2352x1568px. 45-degree field of view. Fundus photo — 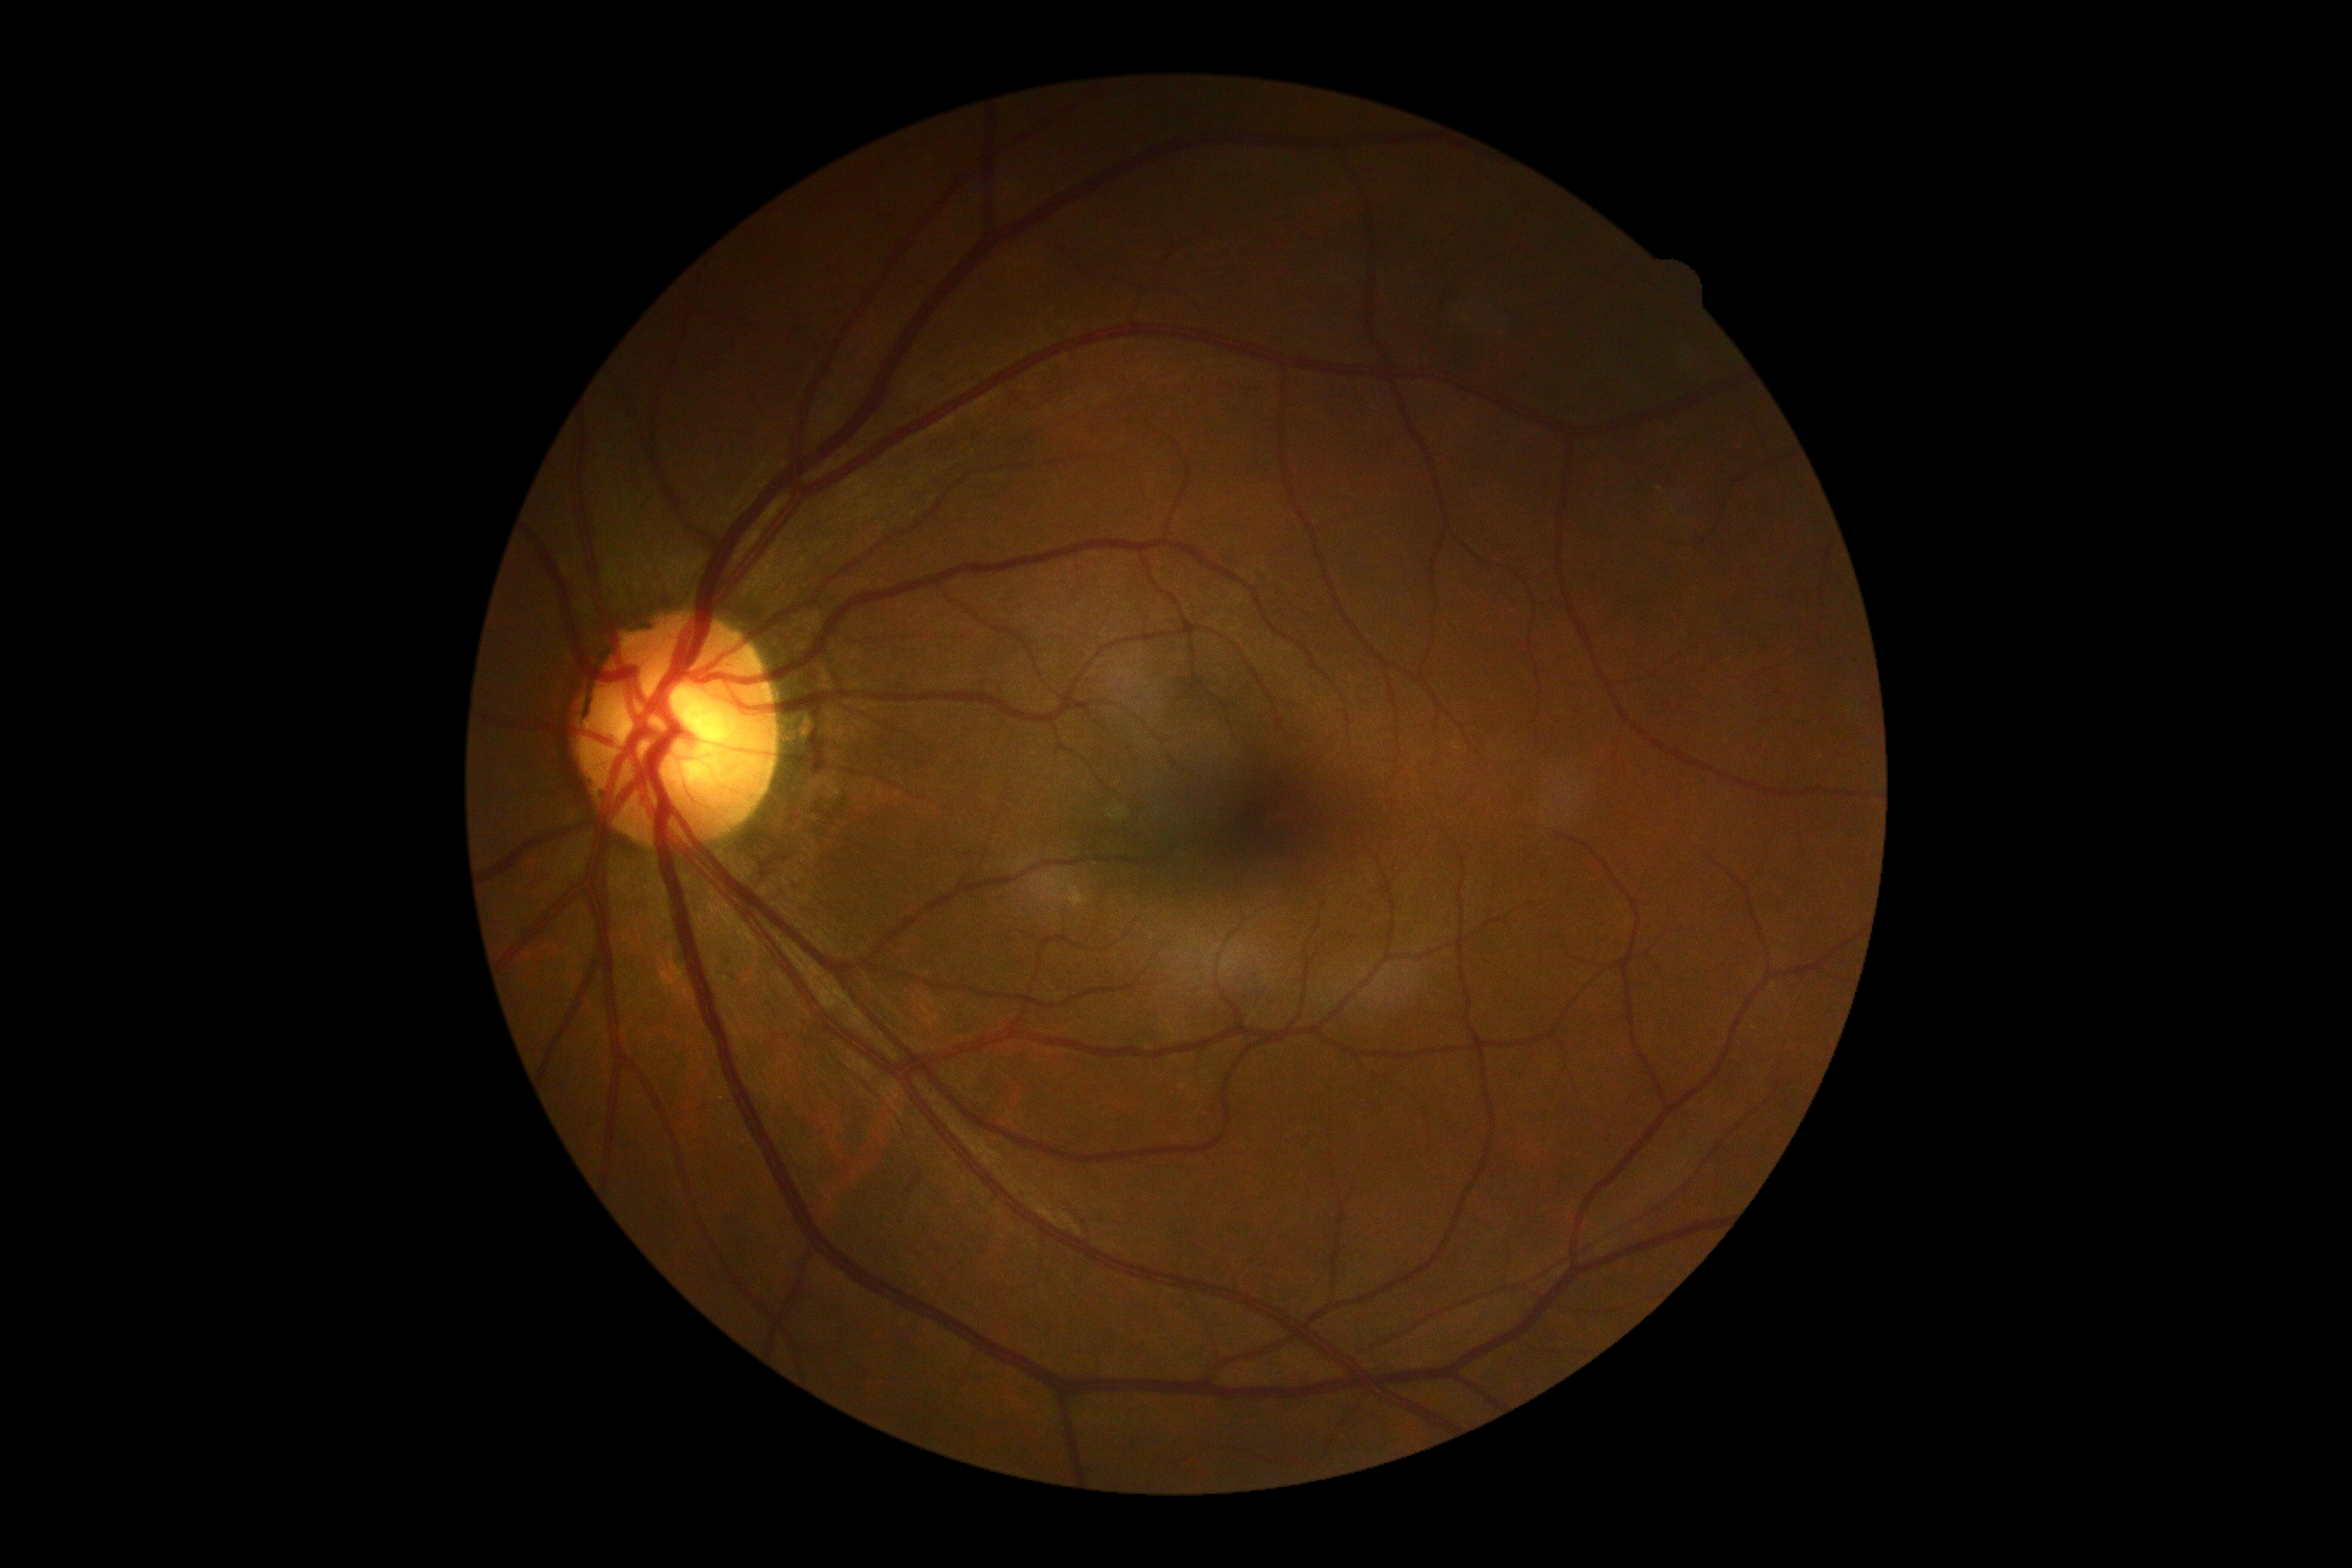 Diabetic retinopathy is grade 0 (no apparent retinopathy).